Nonmydriatic fundus photograph. Modified Davis classification
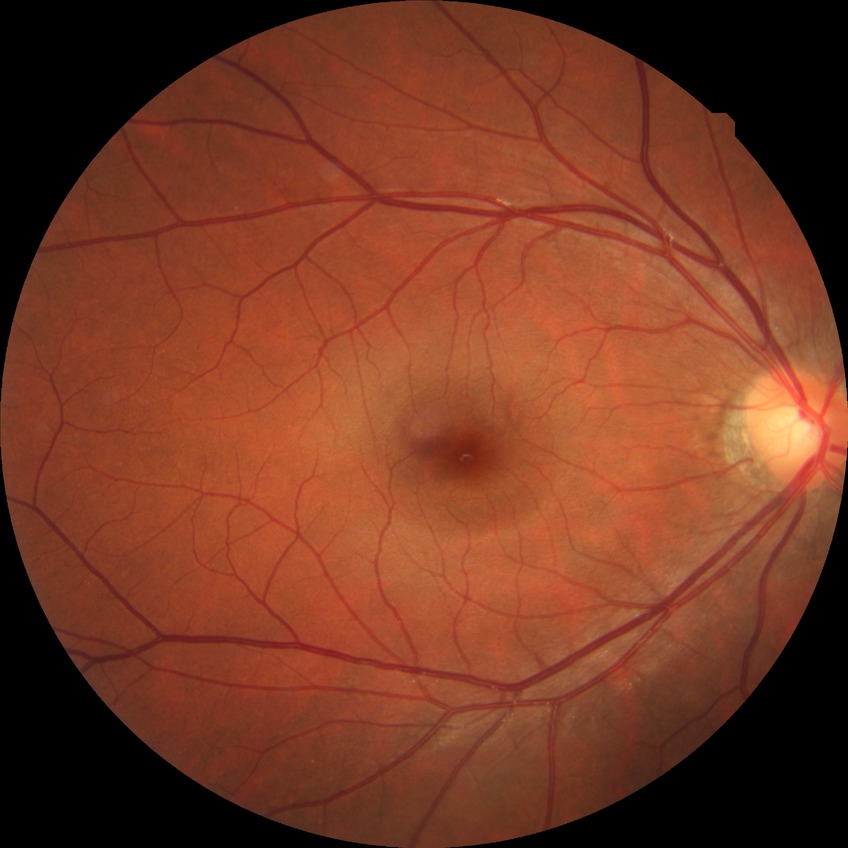 Modified Davis classification is no diabetic retinopathy.